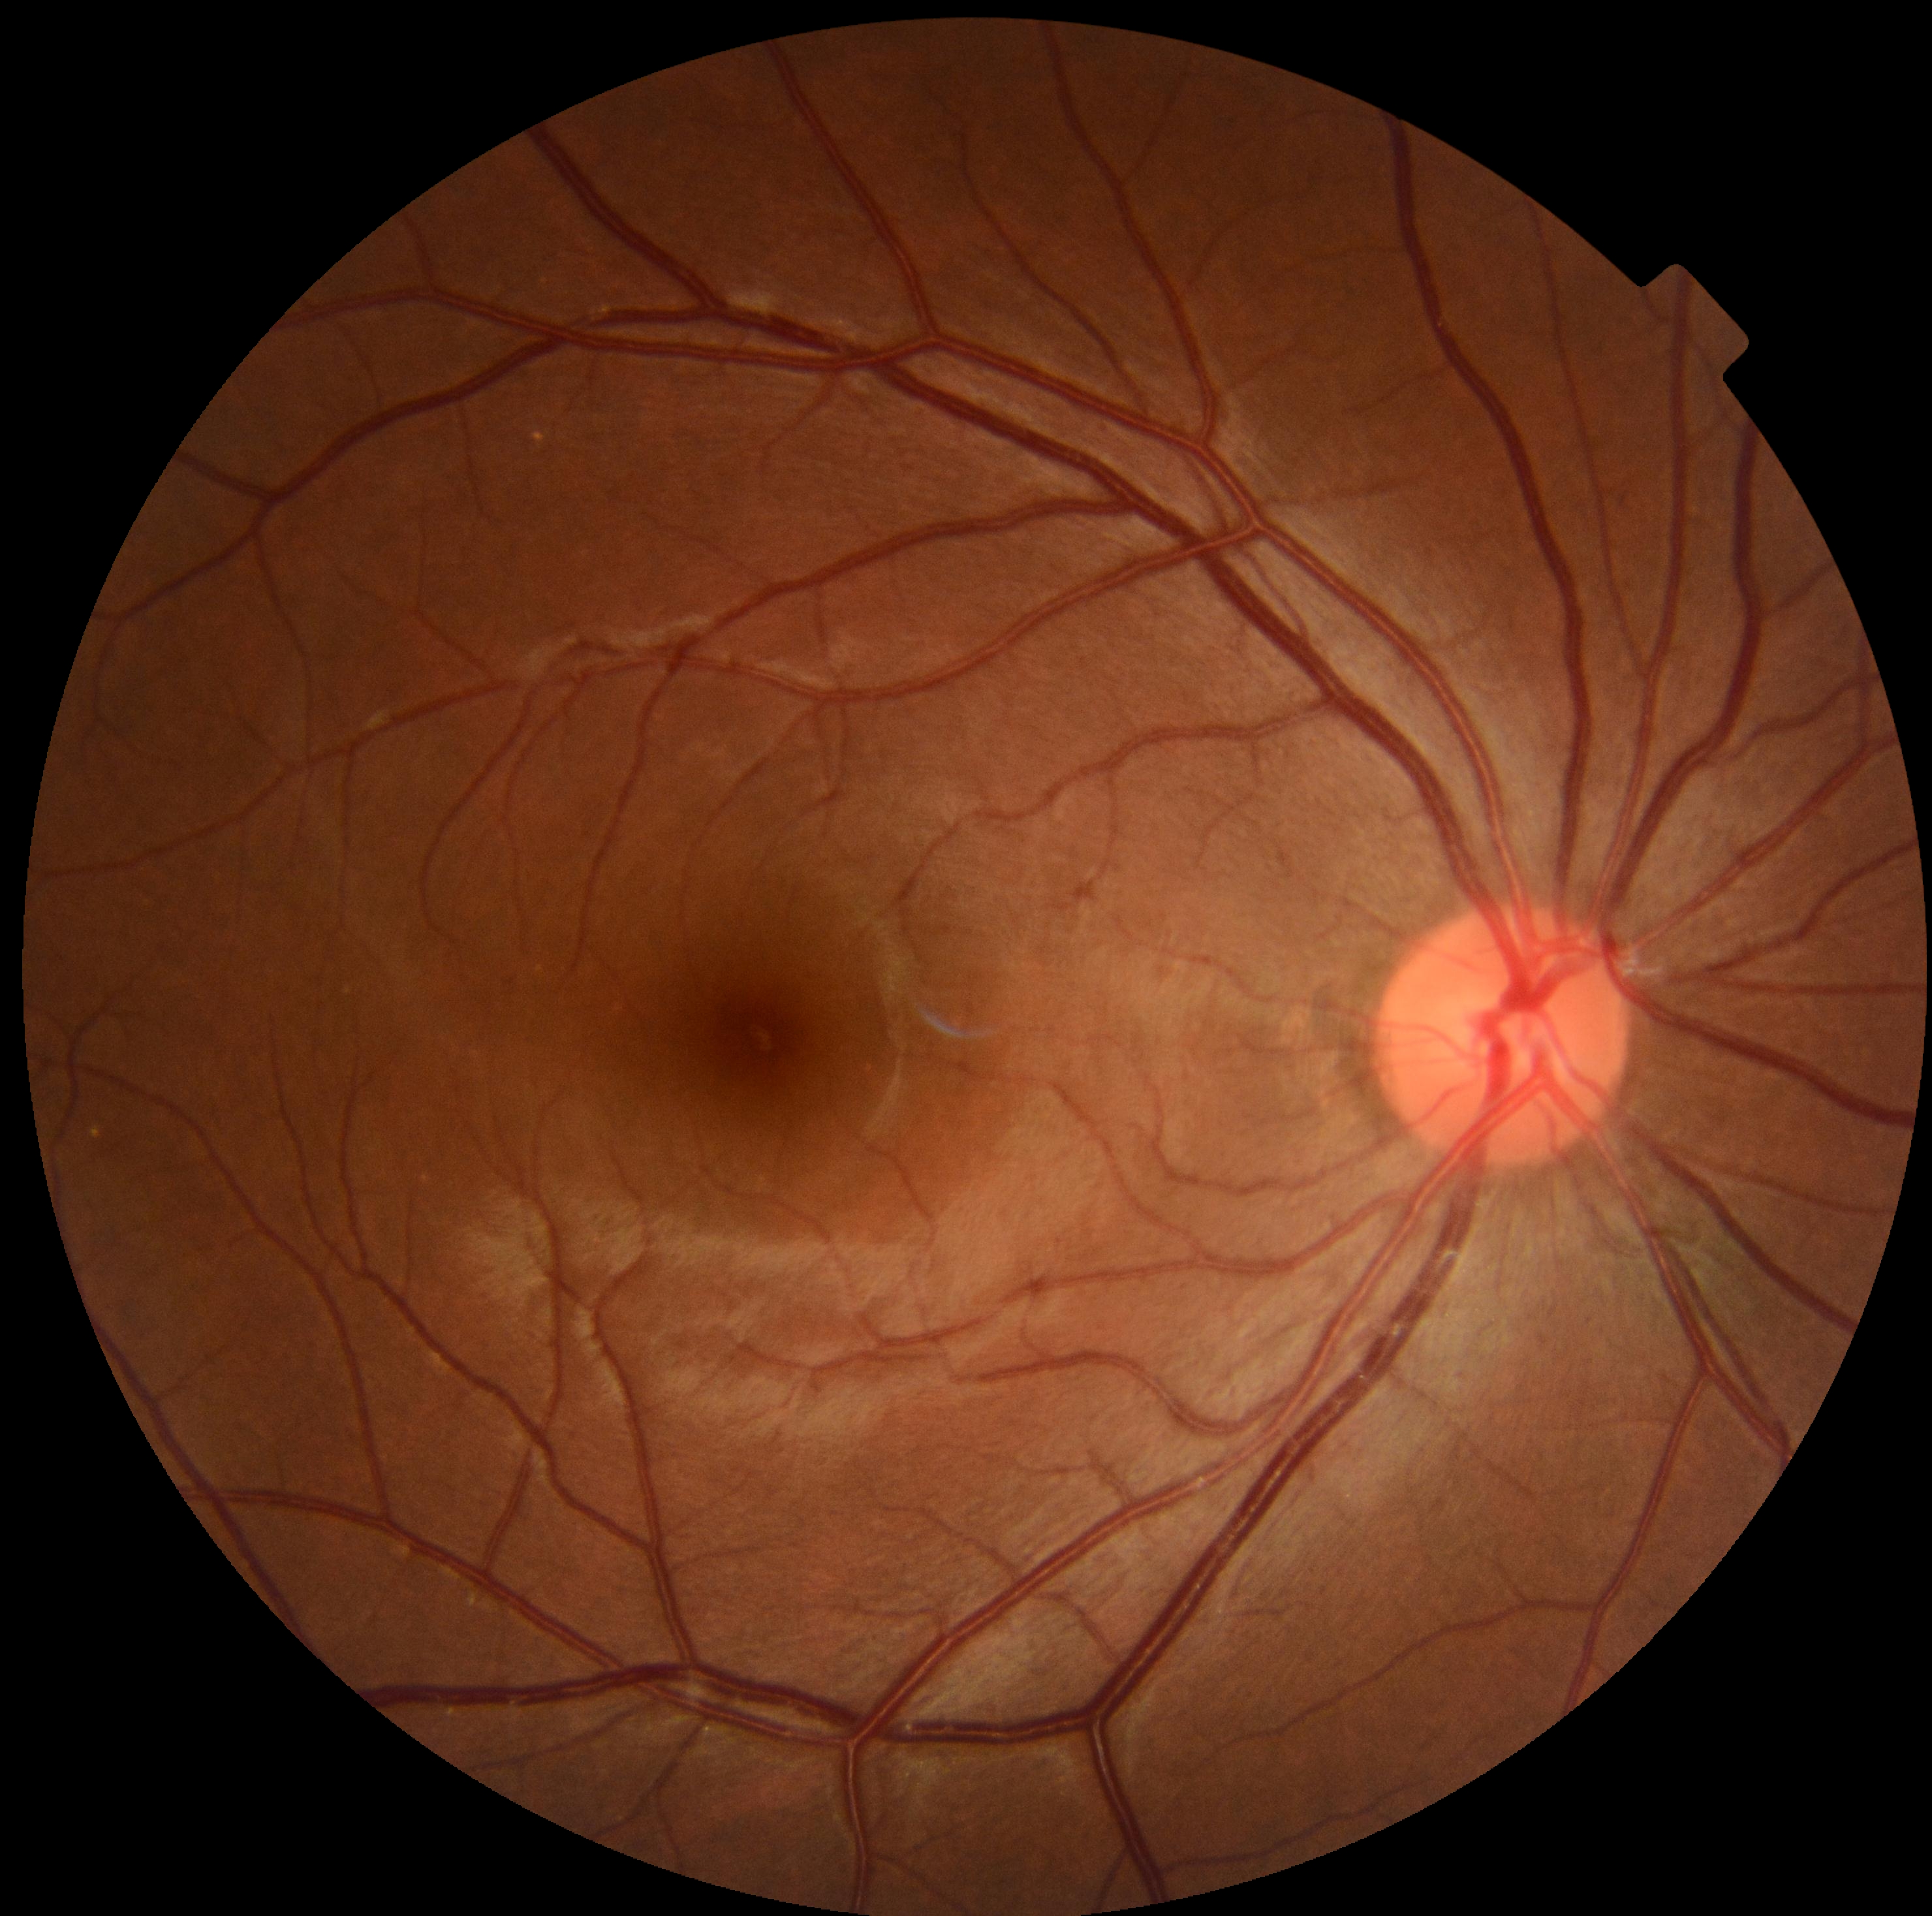 dr_impression: no apparent DR
dr_grade: 0